2352 by 1568 pixels — 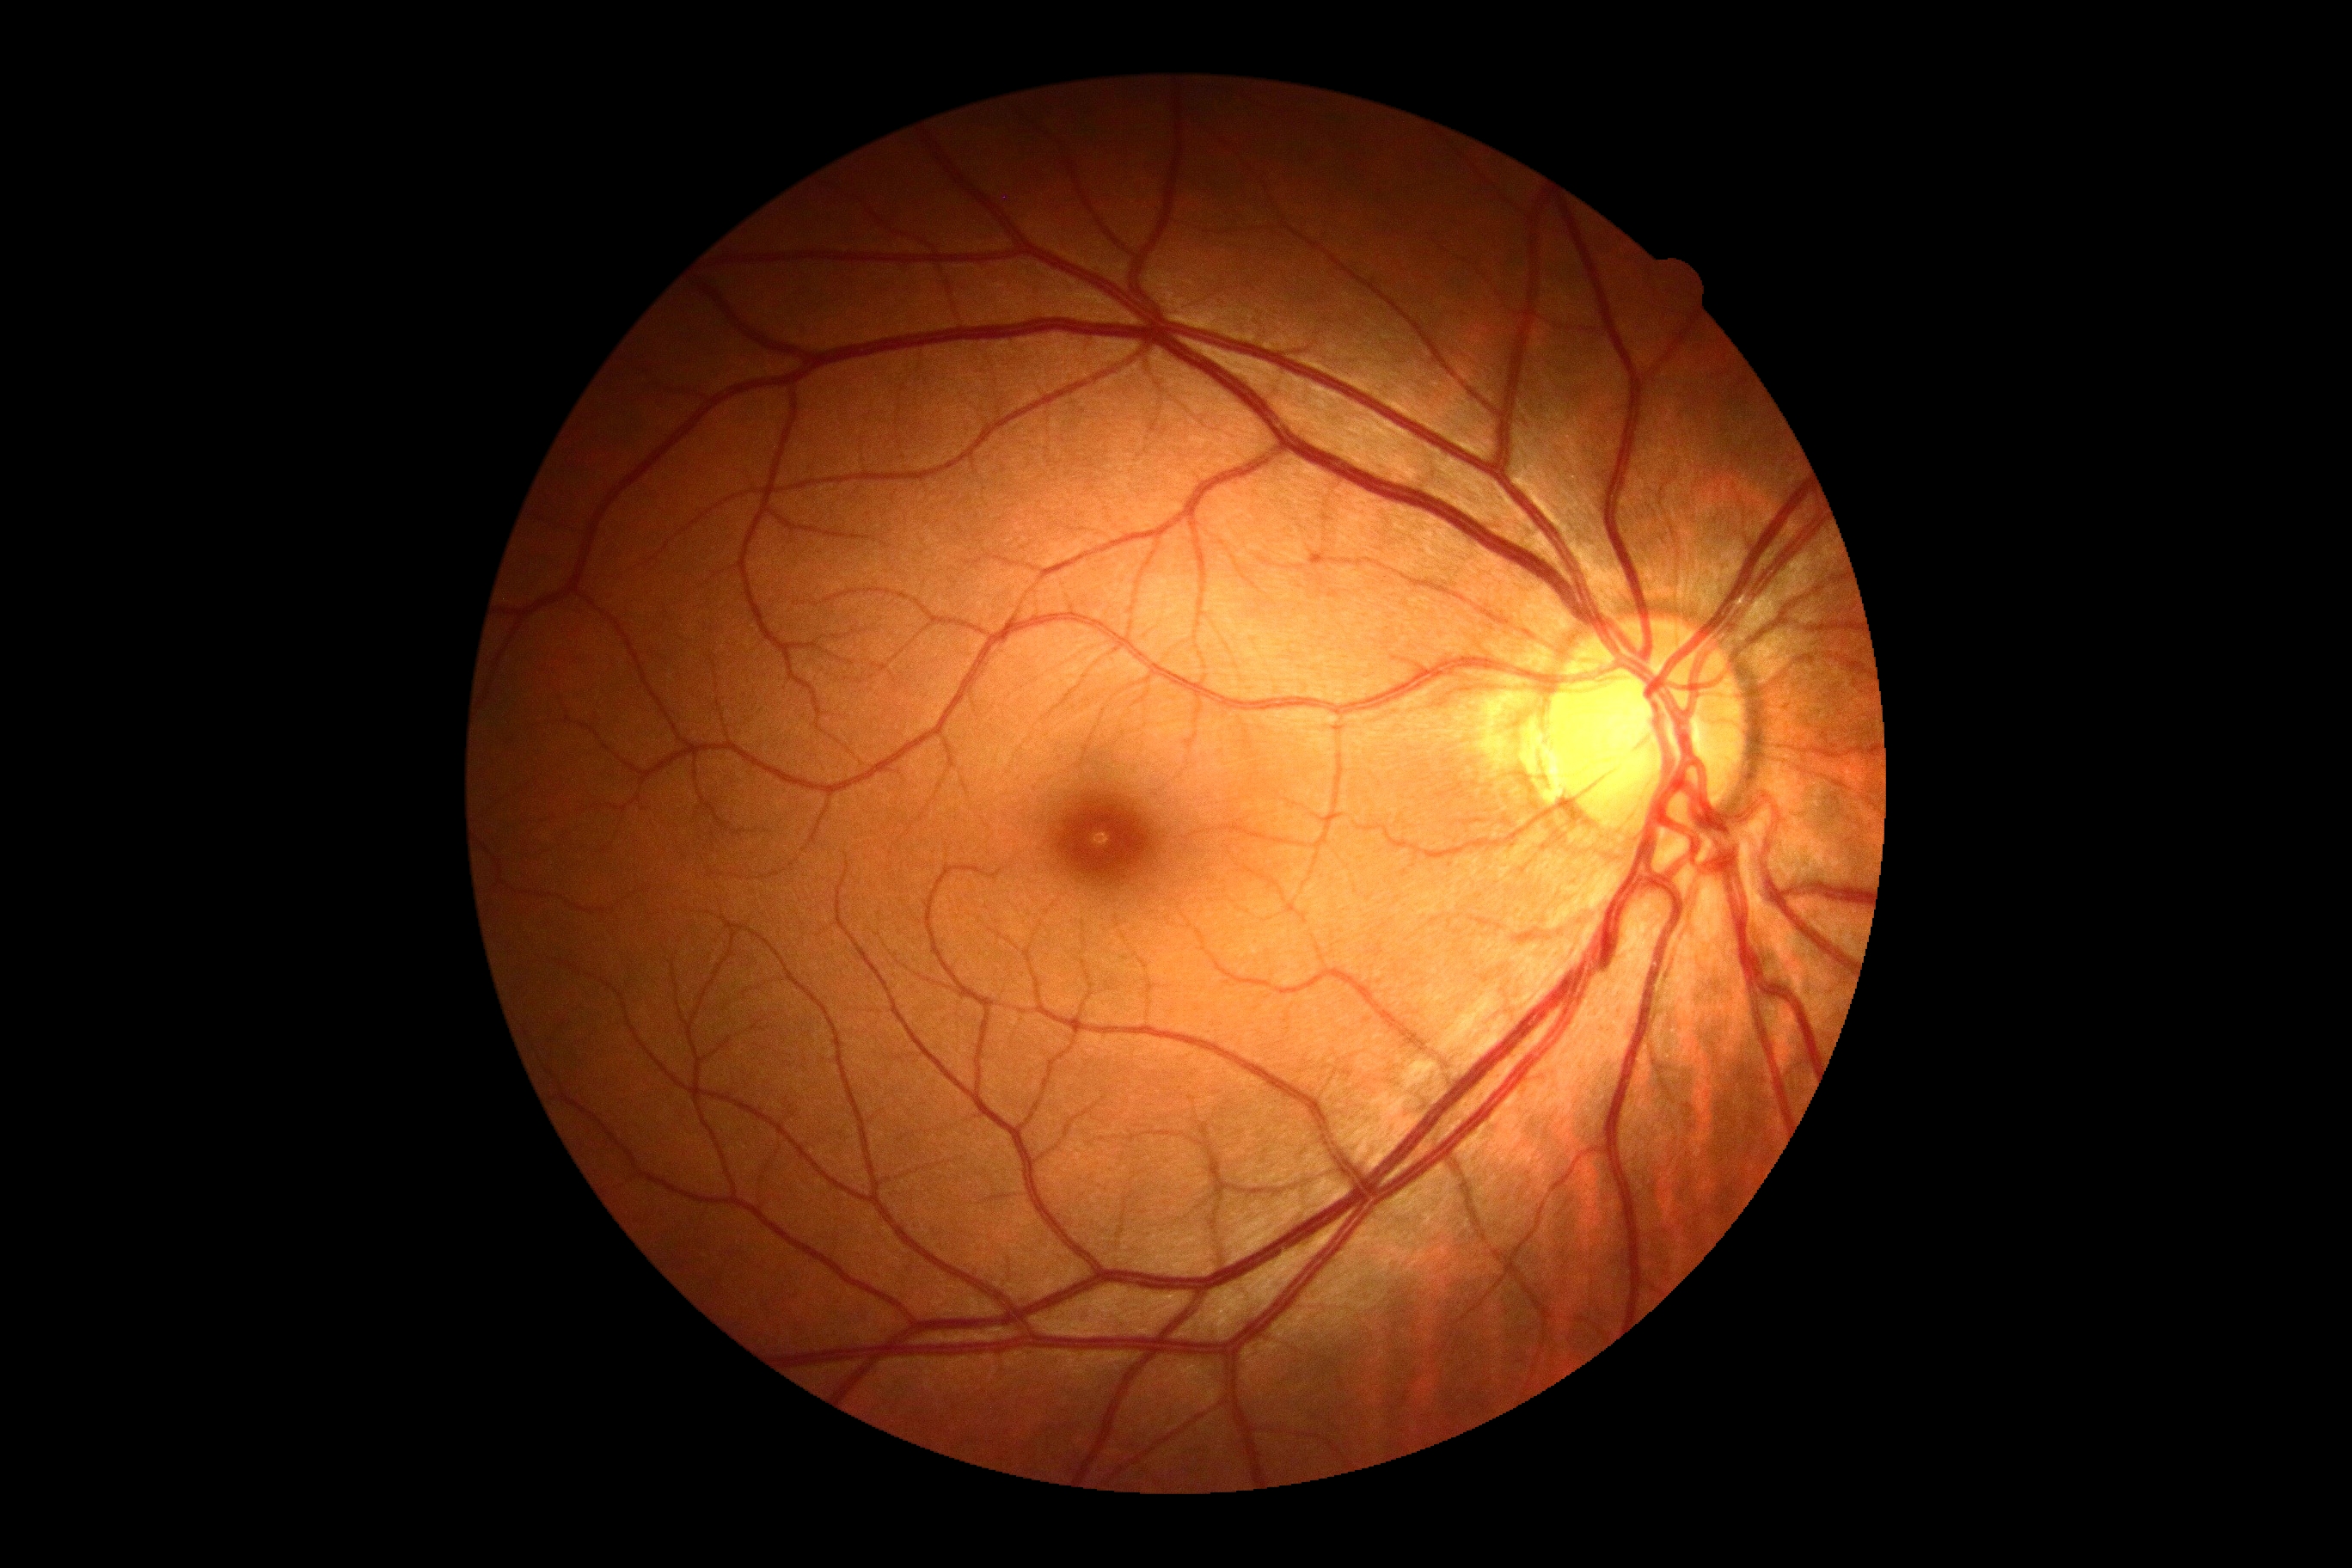 Diabetic retinopathy (DR) is grade 0.